Camera: NIDEK AFC-230; color fundus photograph; no pharmacologic dilation.
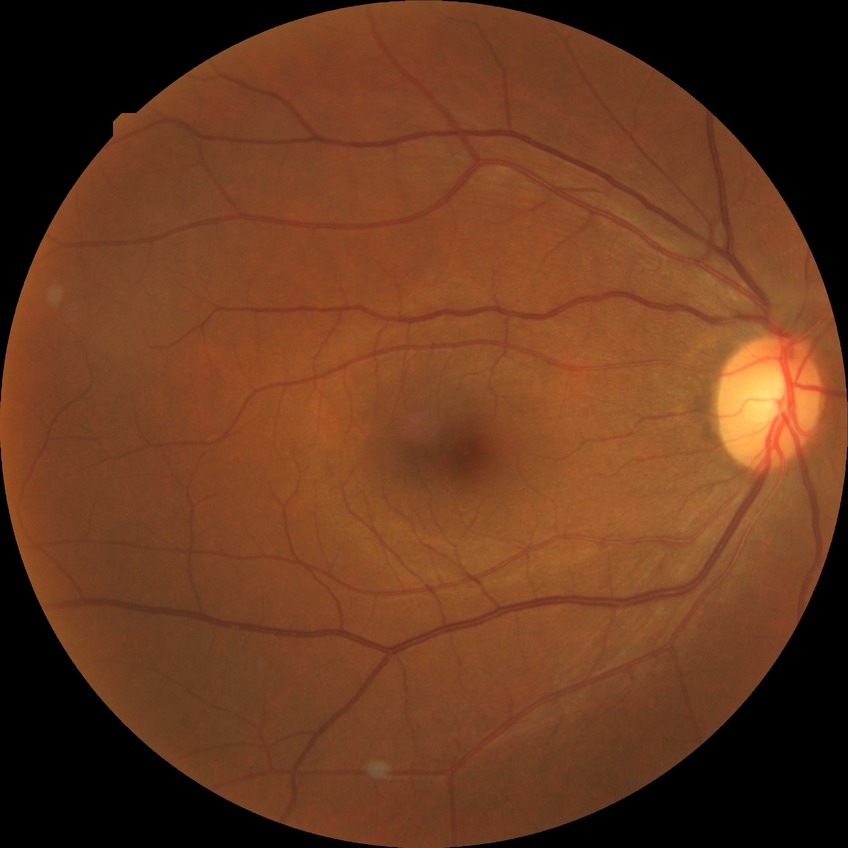

modified Davis classification=no diabetic retinopathy.